Color fundus image; camera: NIDEK AFC-230; 848 x 848 pixels — 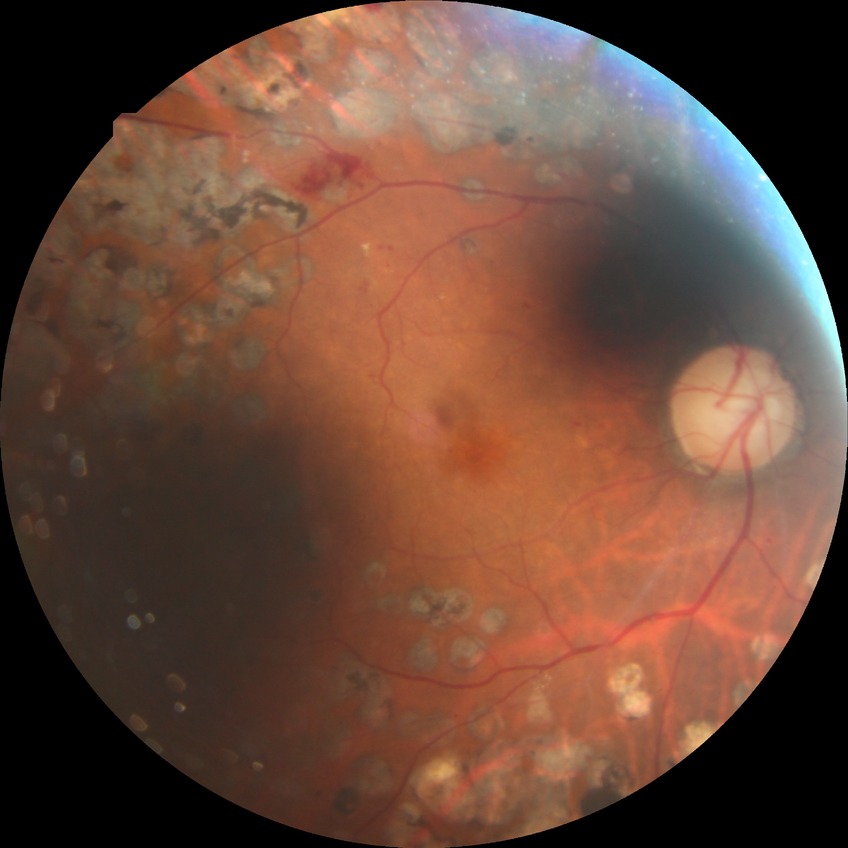
Assessment:
* DR severity: PDR